1932 x 1916 pixels — 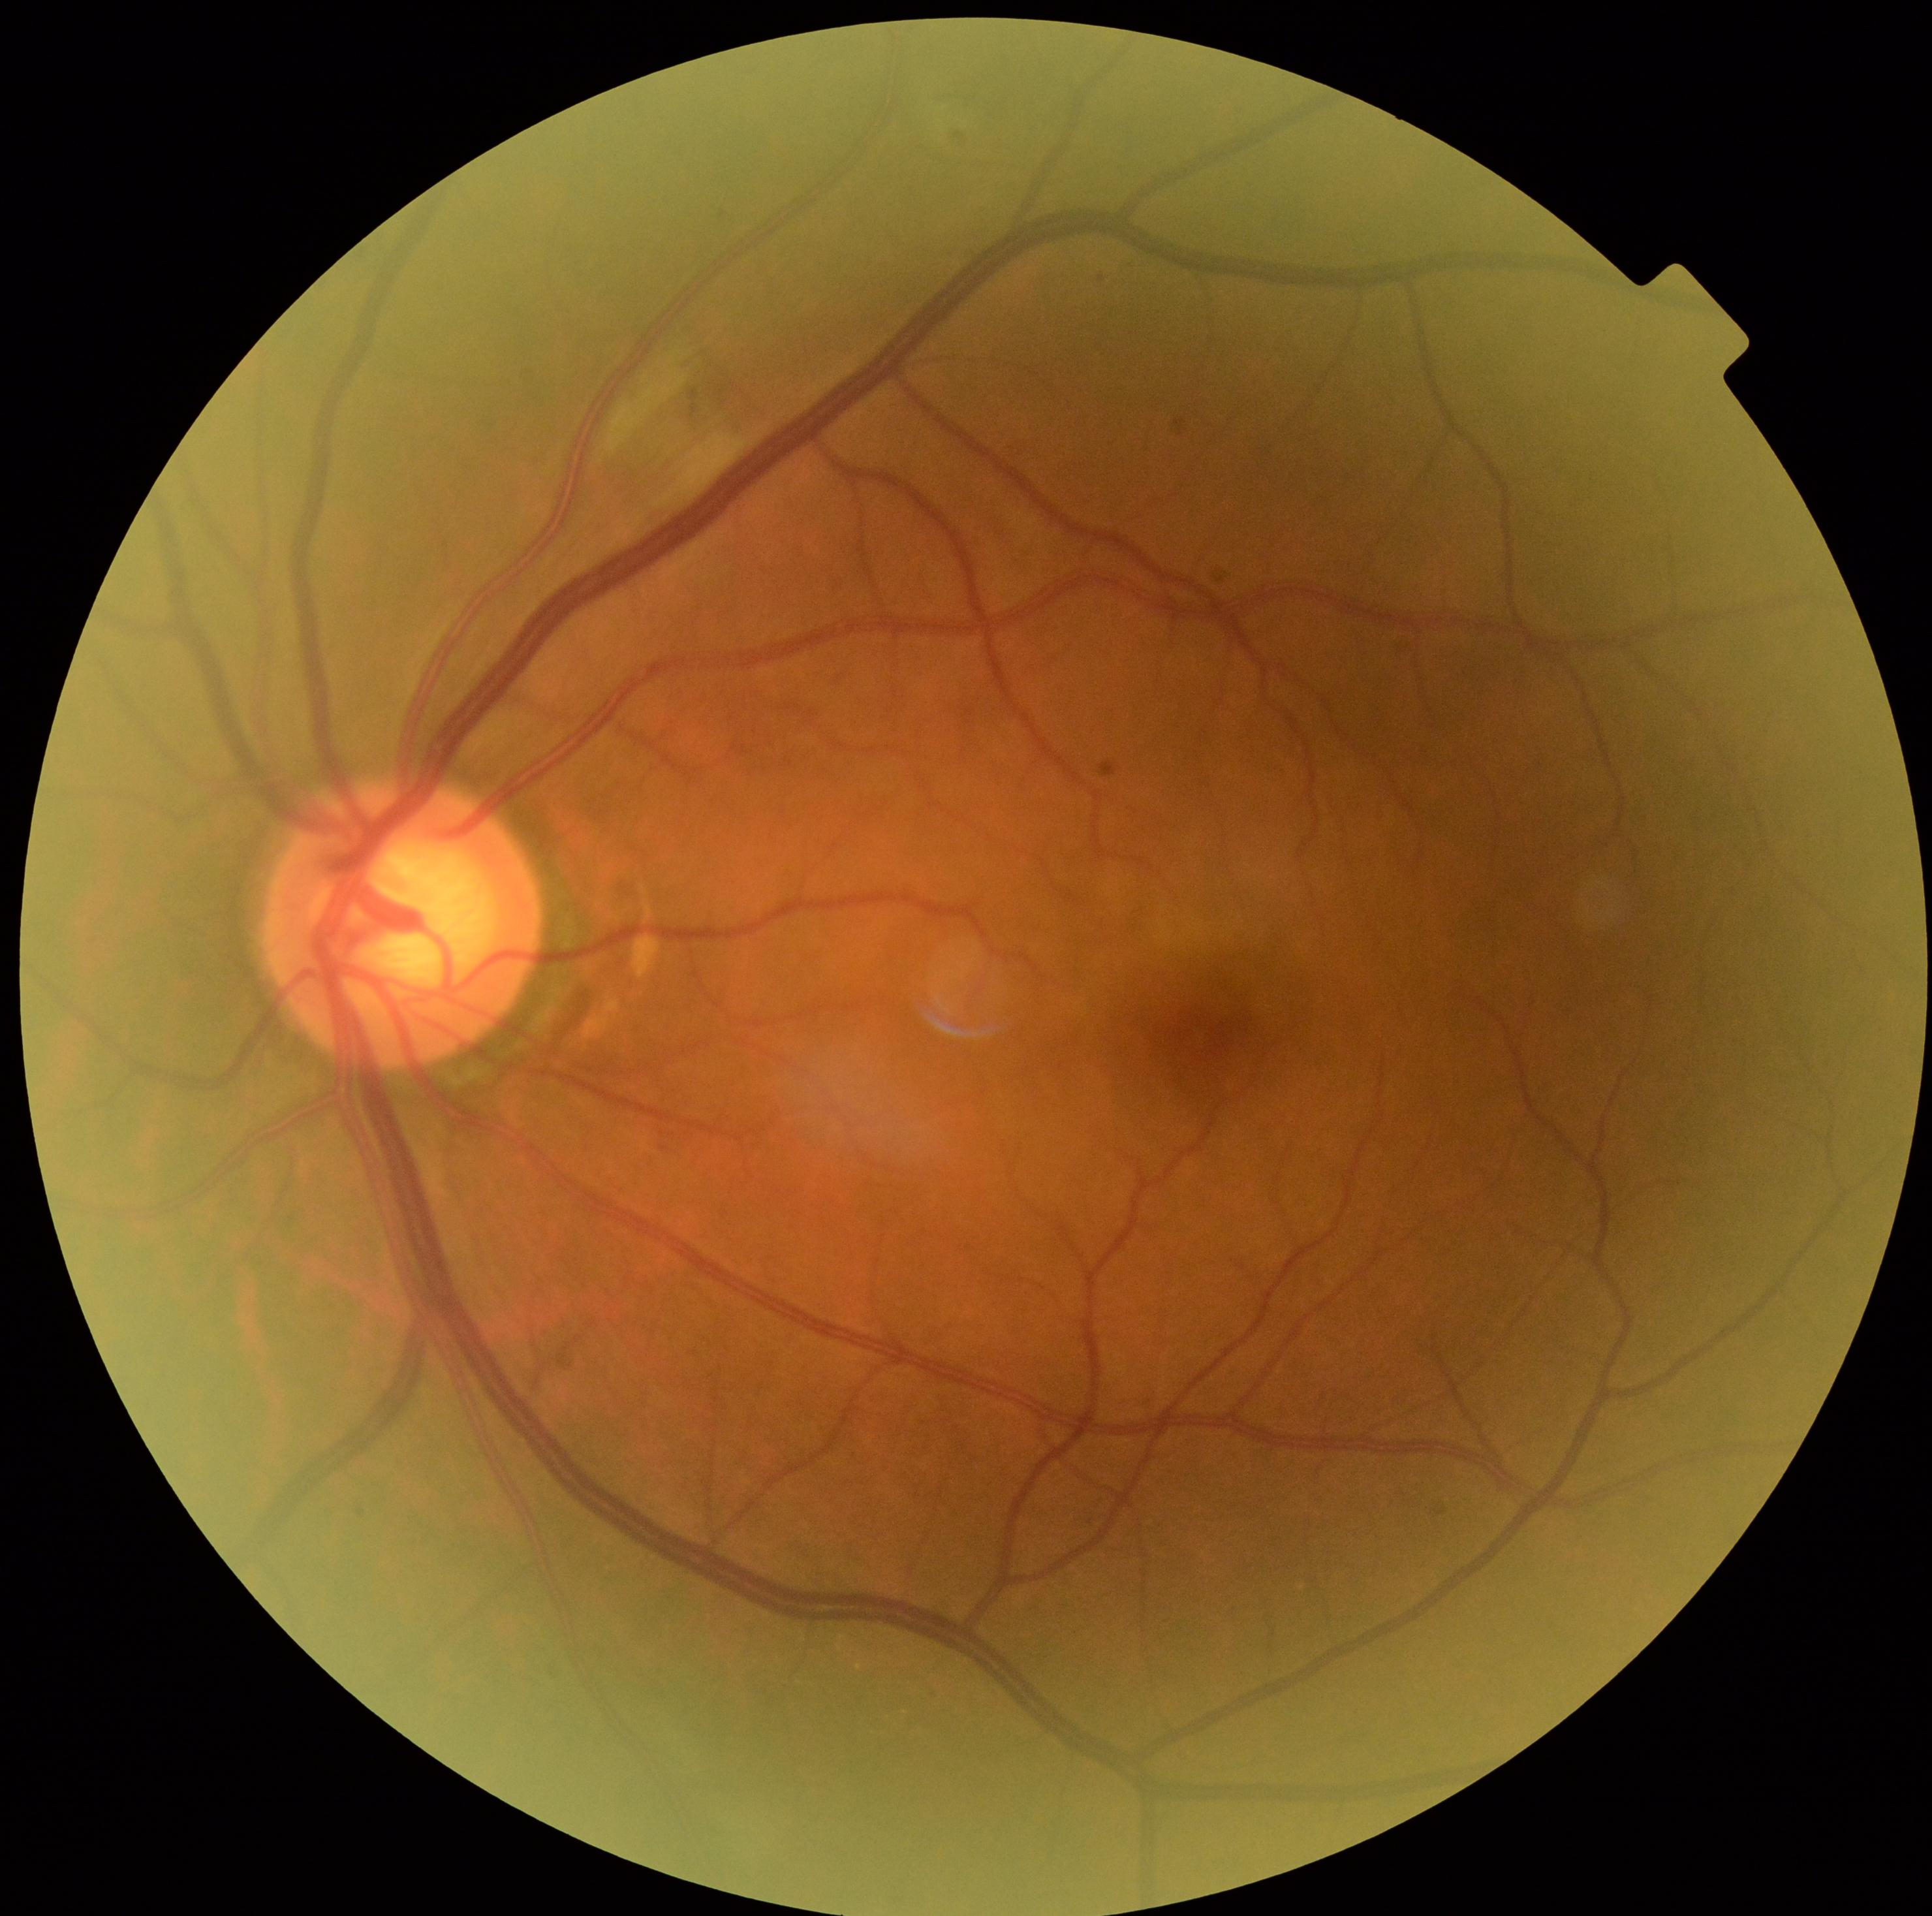
{"dr_grade": "grade 2 (moderate NPDR)"}